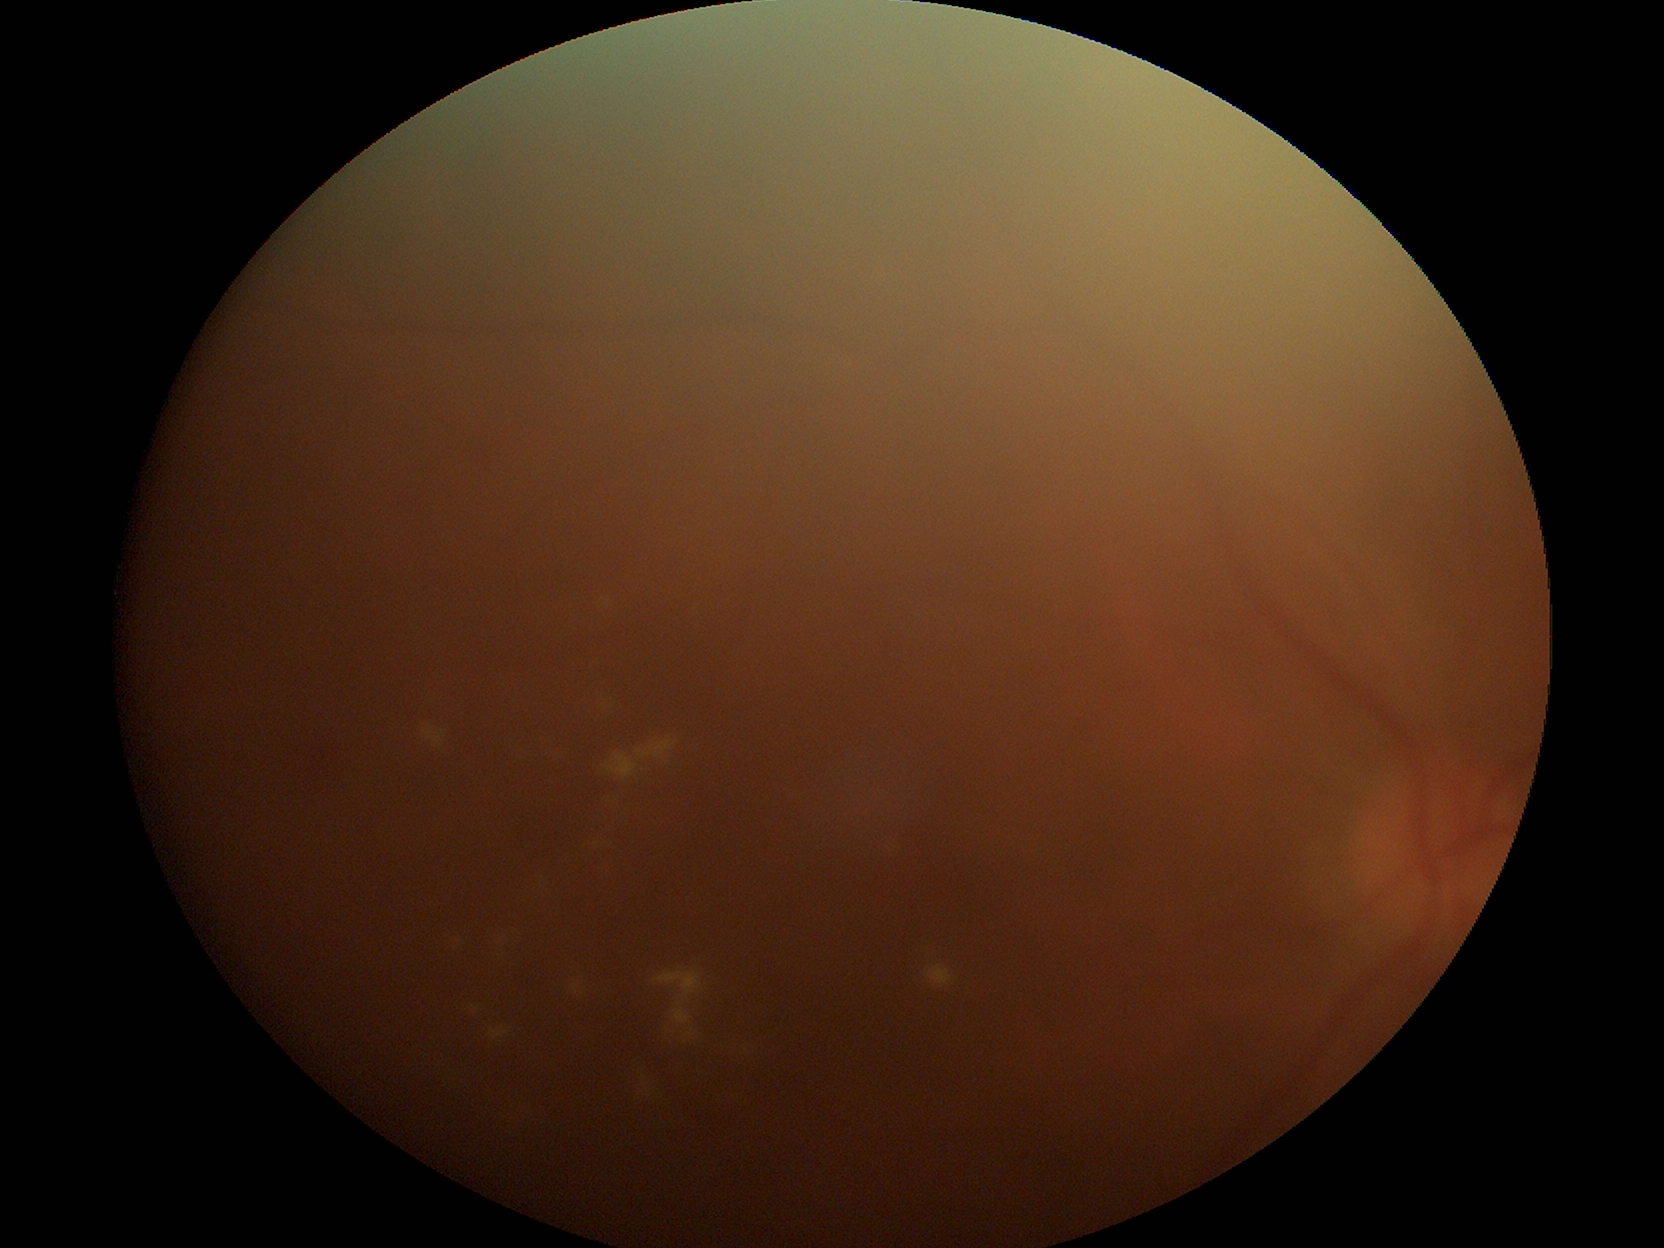 DR: grade 2.
Disease class: non-proliferative diabetic retinopathy.